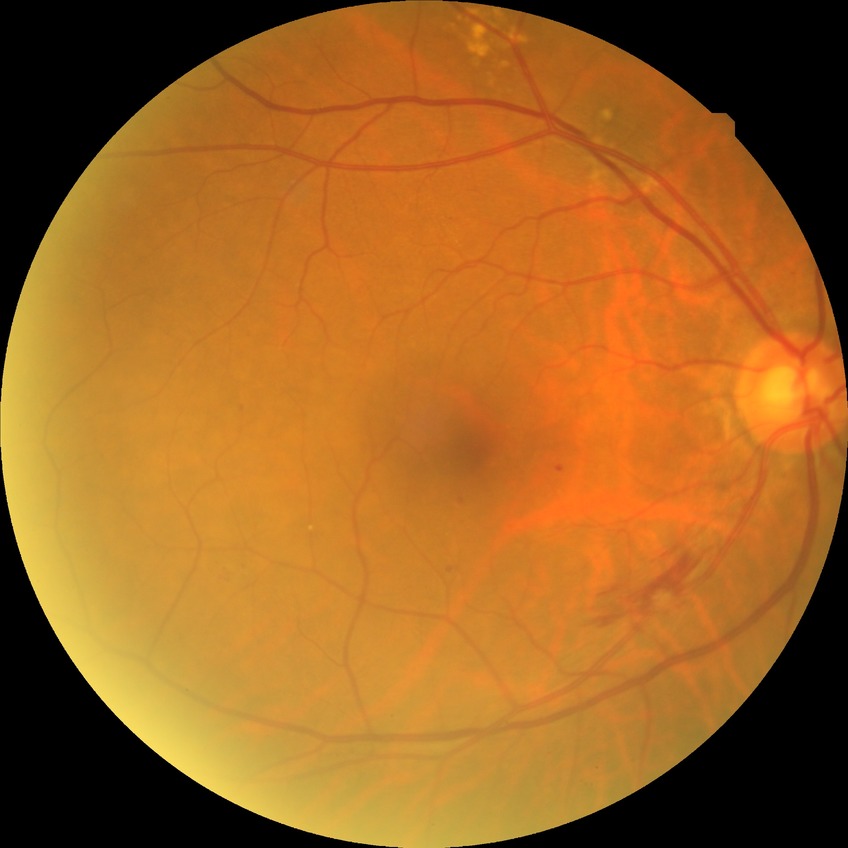

diabetic retinopathy (DR) = simple diabetic retinopathy (SDR).